Image size 848x848; without pupil dilation; NIDEK AFC-230: 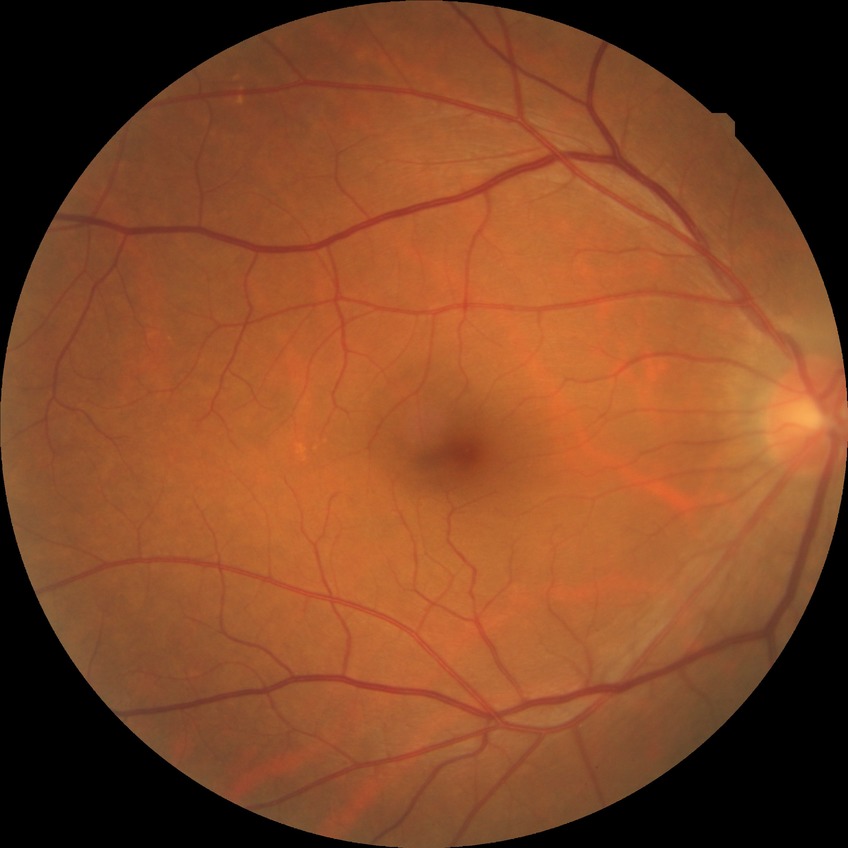
diabetic retinopathy (DR)@no diabetic retinopathy (NDR).